100° field of view (Phoenix ICON). Wide-field fundus photograph from neonatal ROP screening: 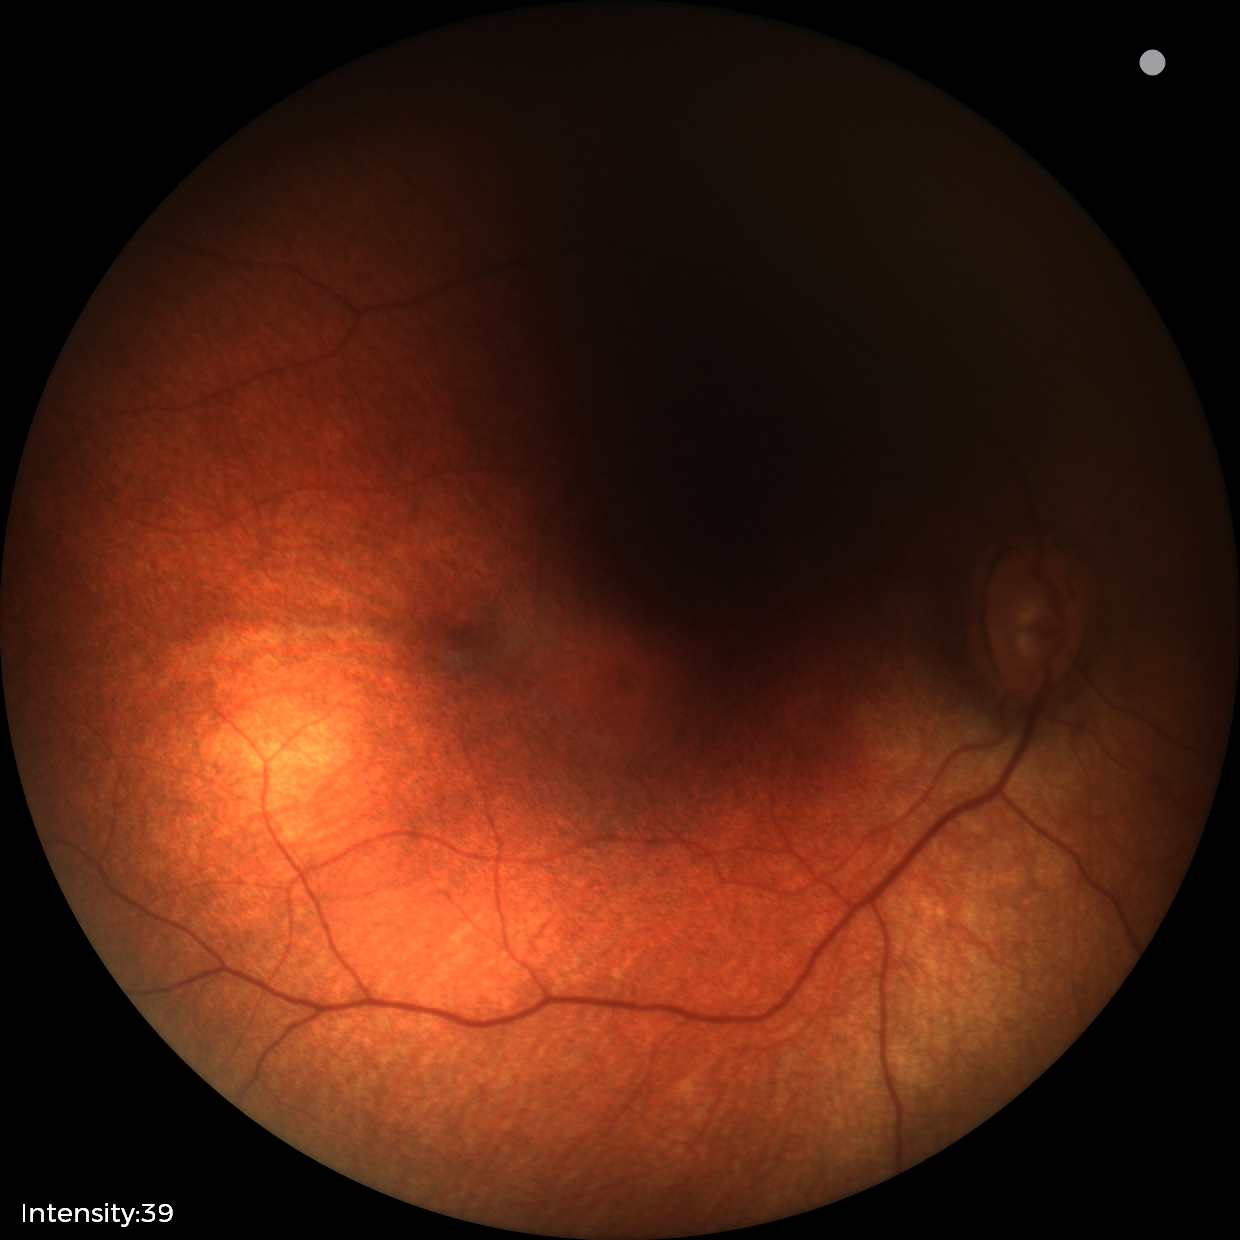 Screening examination diagnosed as physiological.